Wide-field contact fundus photograph of an infant — 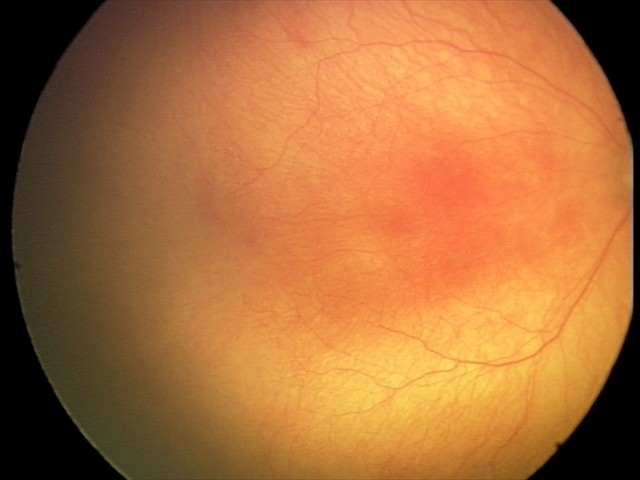

Examination diagnosed as aggressive retinopathy of prematurity (A-ROP). With plus disease.